1932x1932. Topcon TRC-NW8
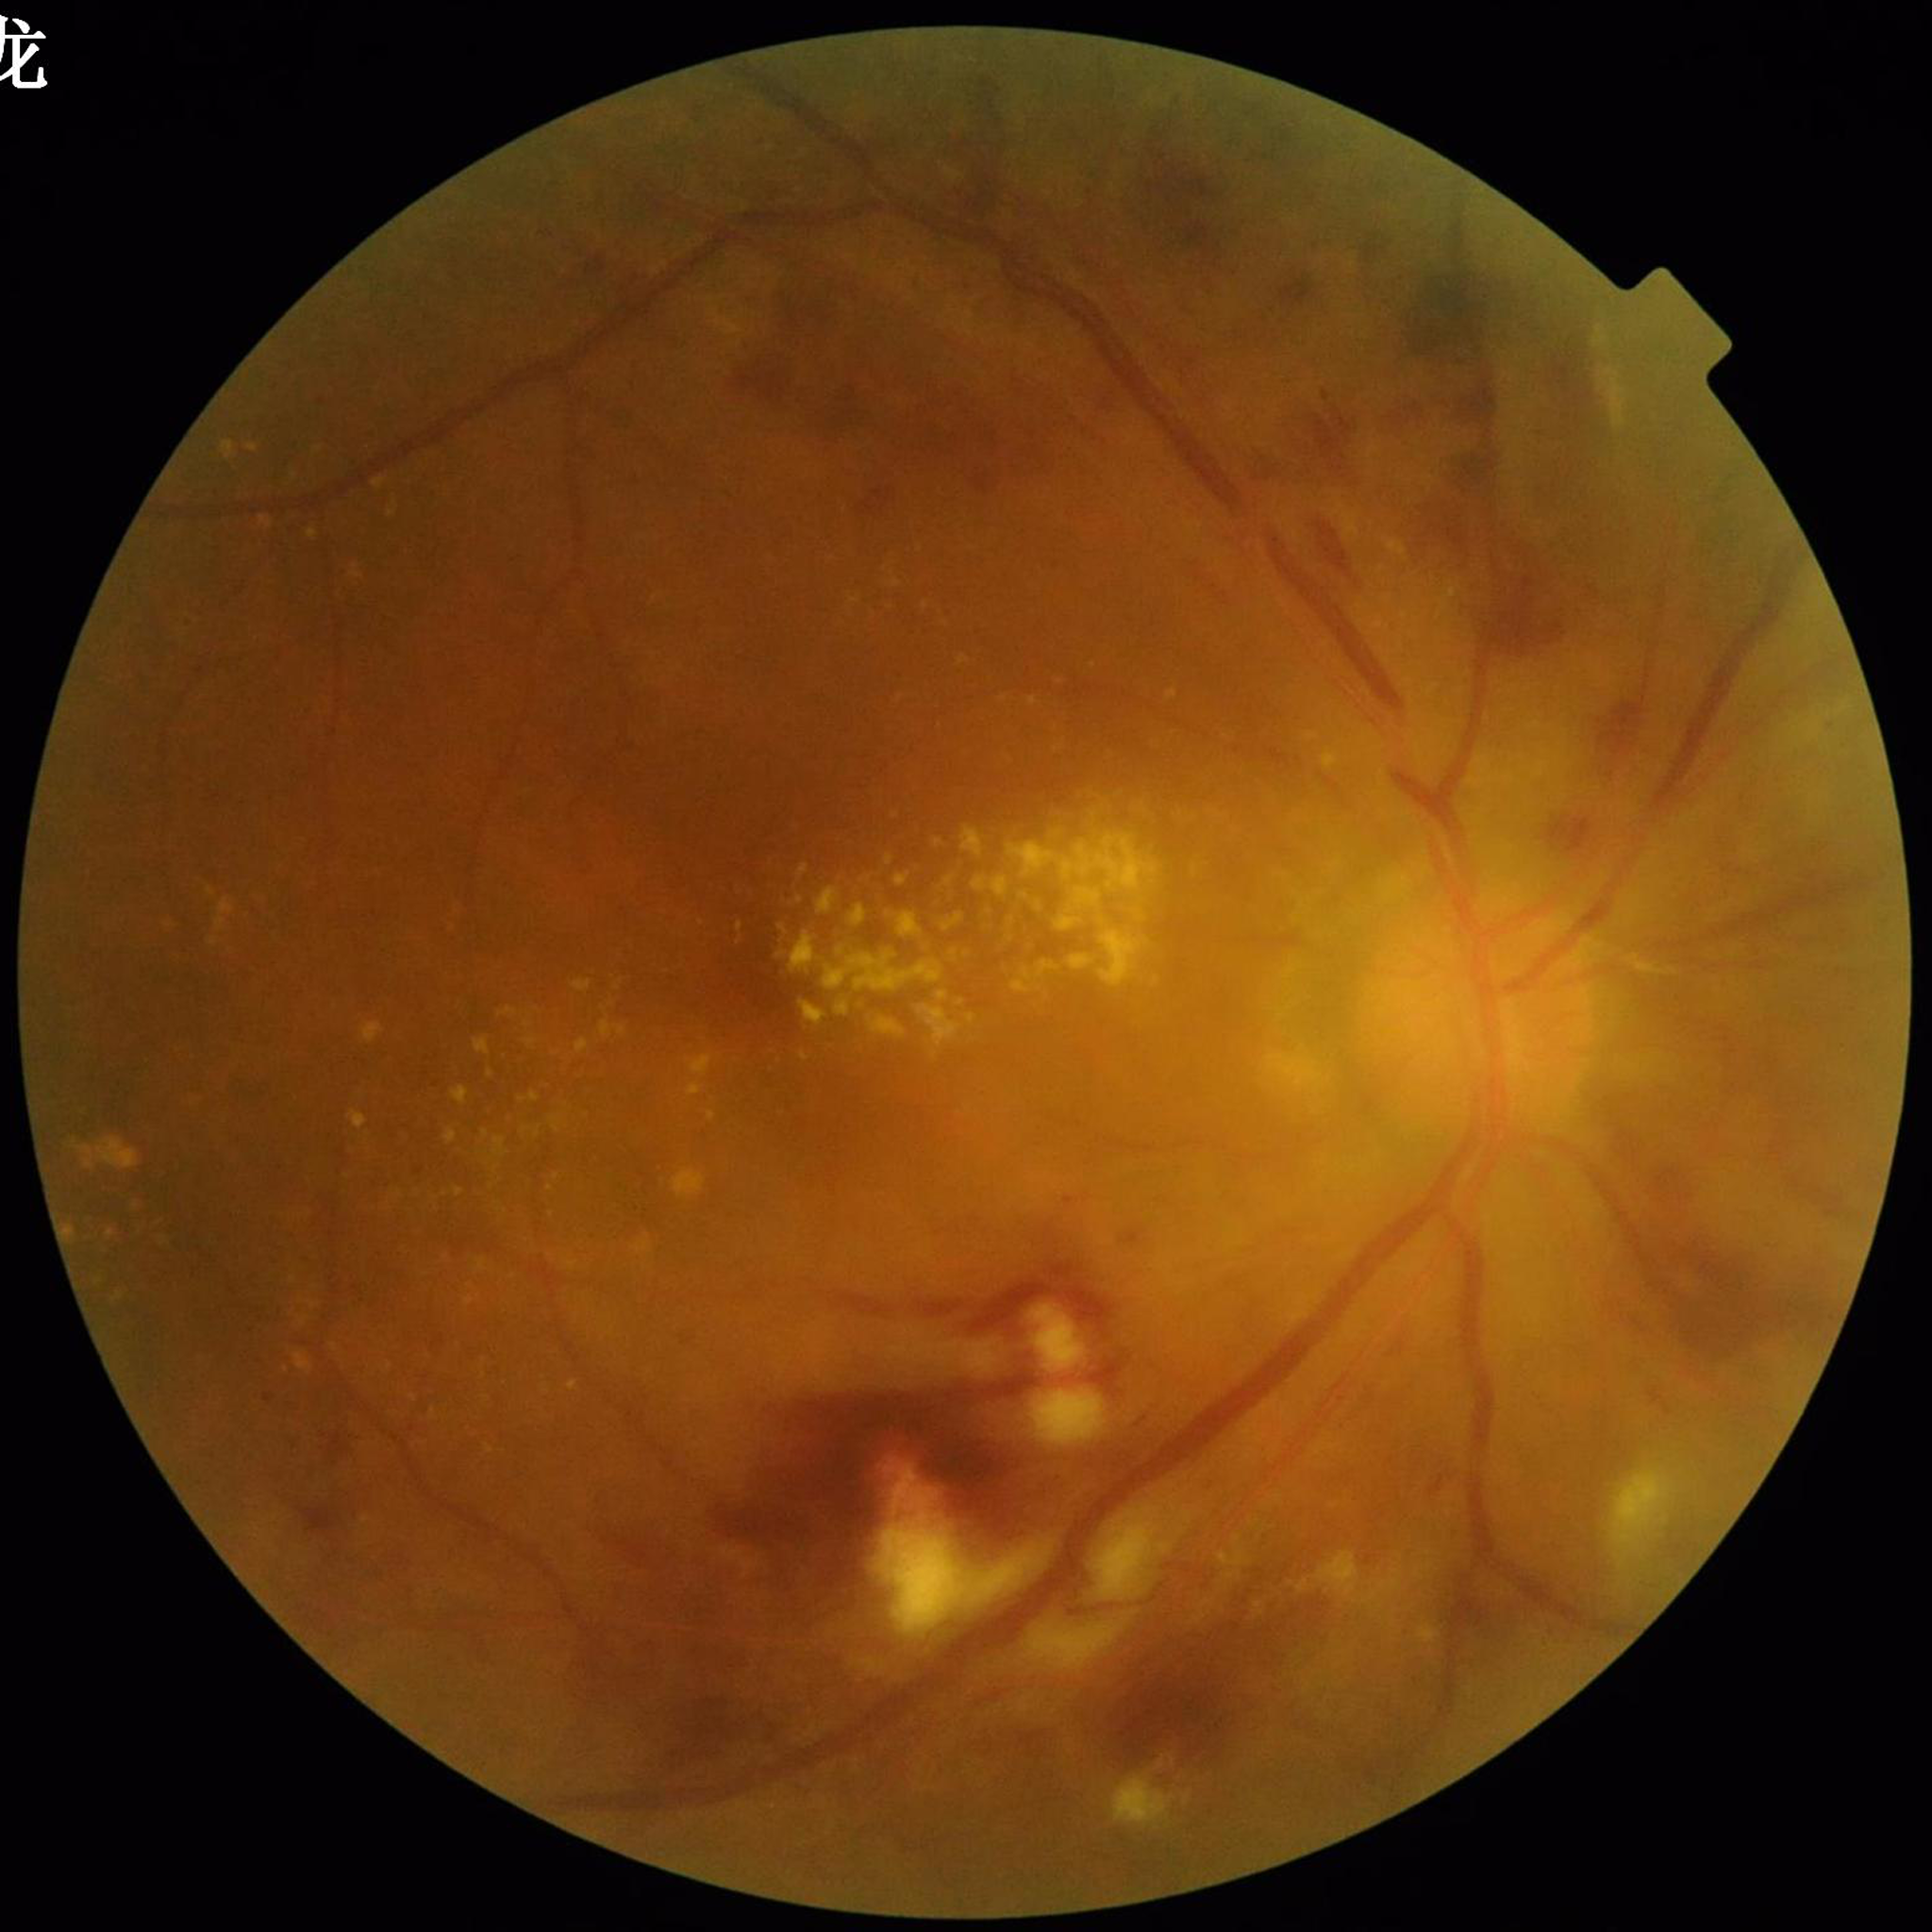
Clinical diagnosis: diabetic retinopathy (DR); Quality assessment: reduced — blur.